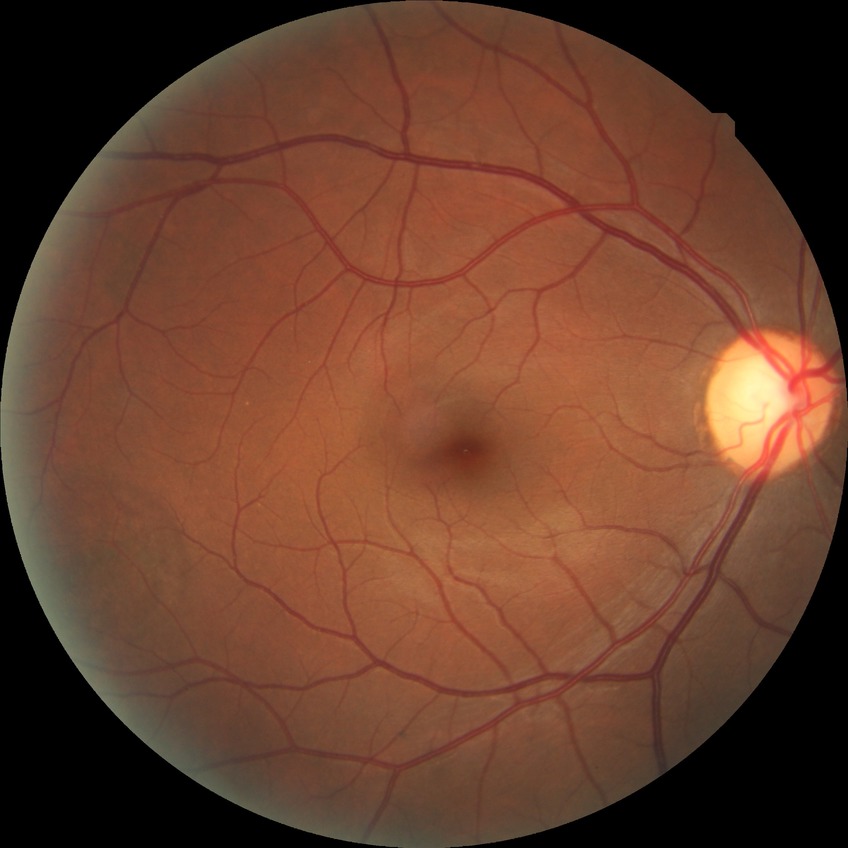

Davis grading: no diabetic retinopathy.